Natus RetCam Envision, 130° FOV. Wide-field fundus photograph of an infant — 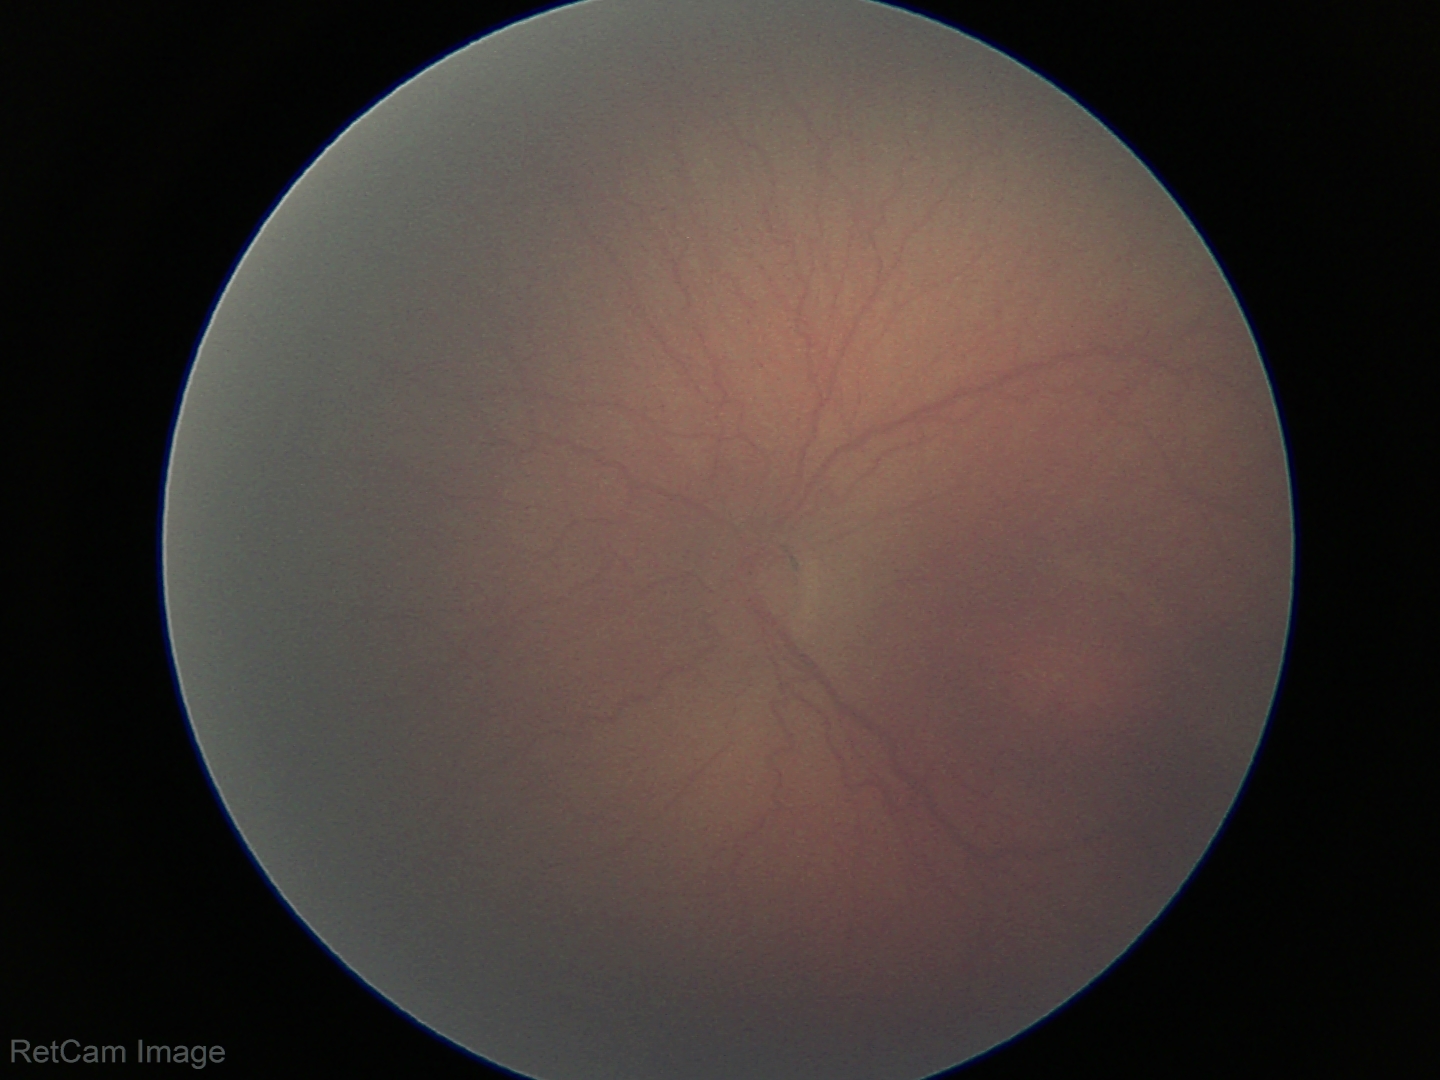
Diagnosis = retinopathy of prematurity (ROP) stage 2 — ridge with height and width at the demarcation line
plus form = absent